2361 x 1568 pixels · FOV: 50 degrees · fundus photo: 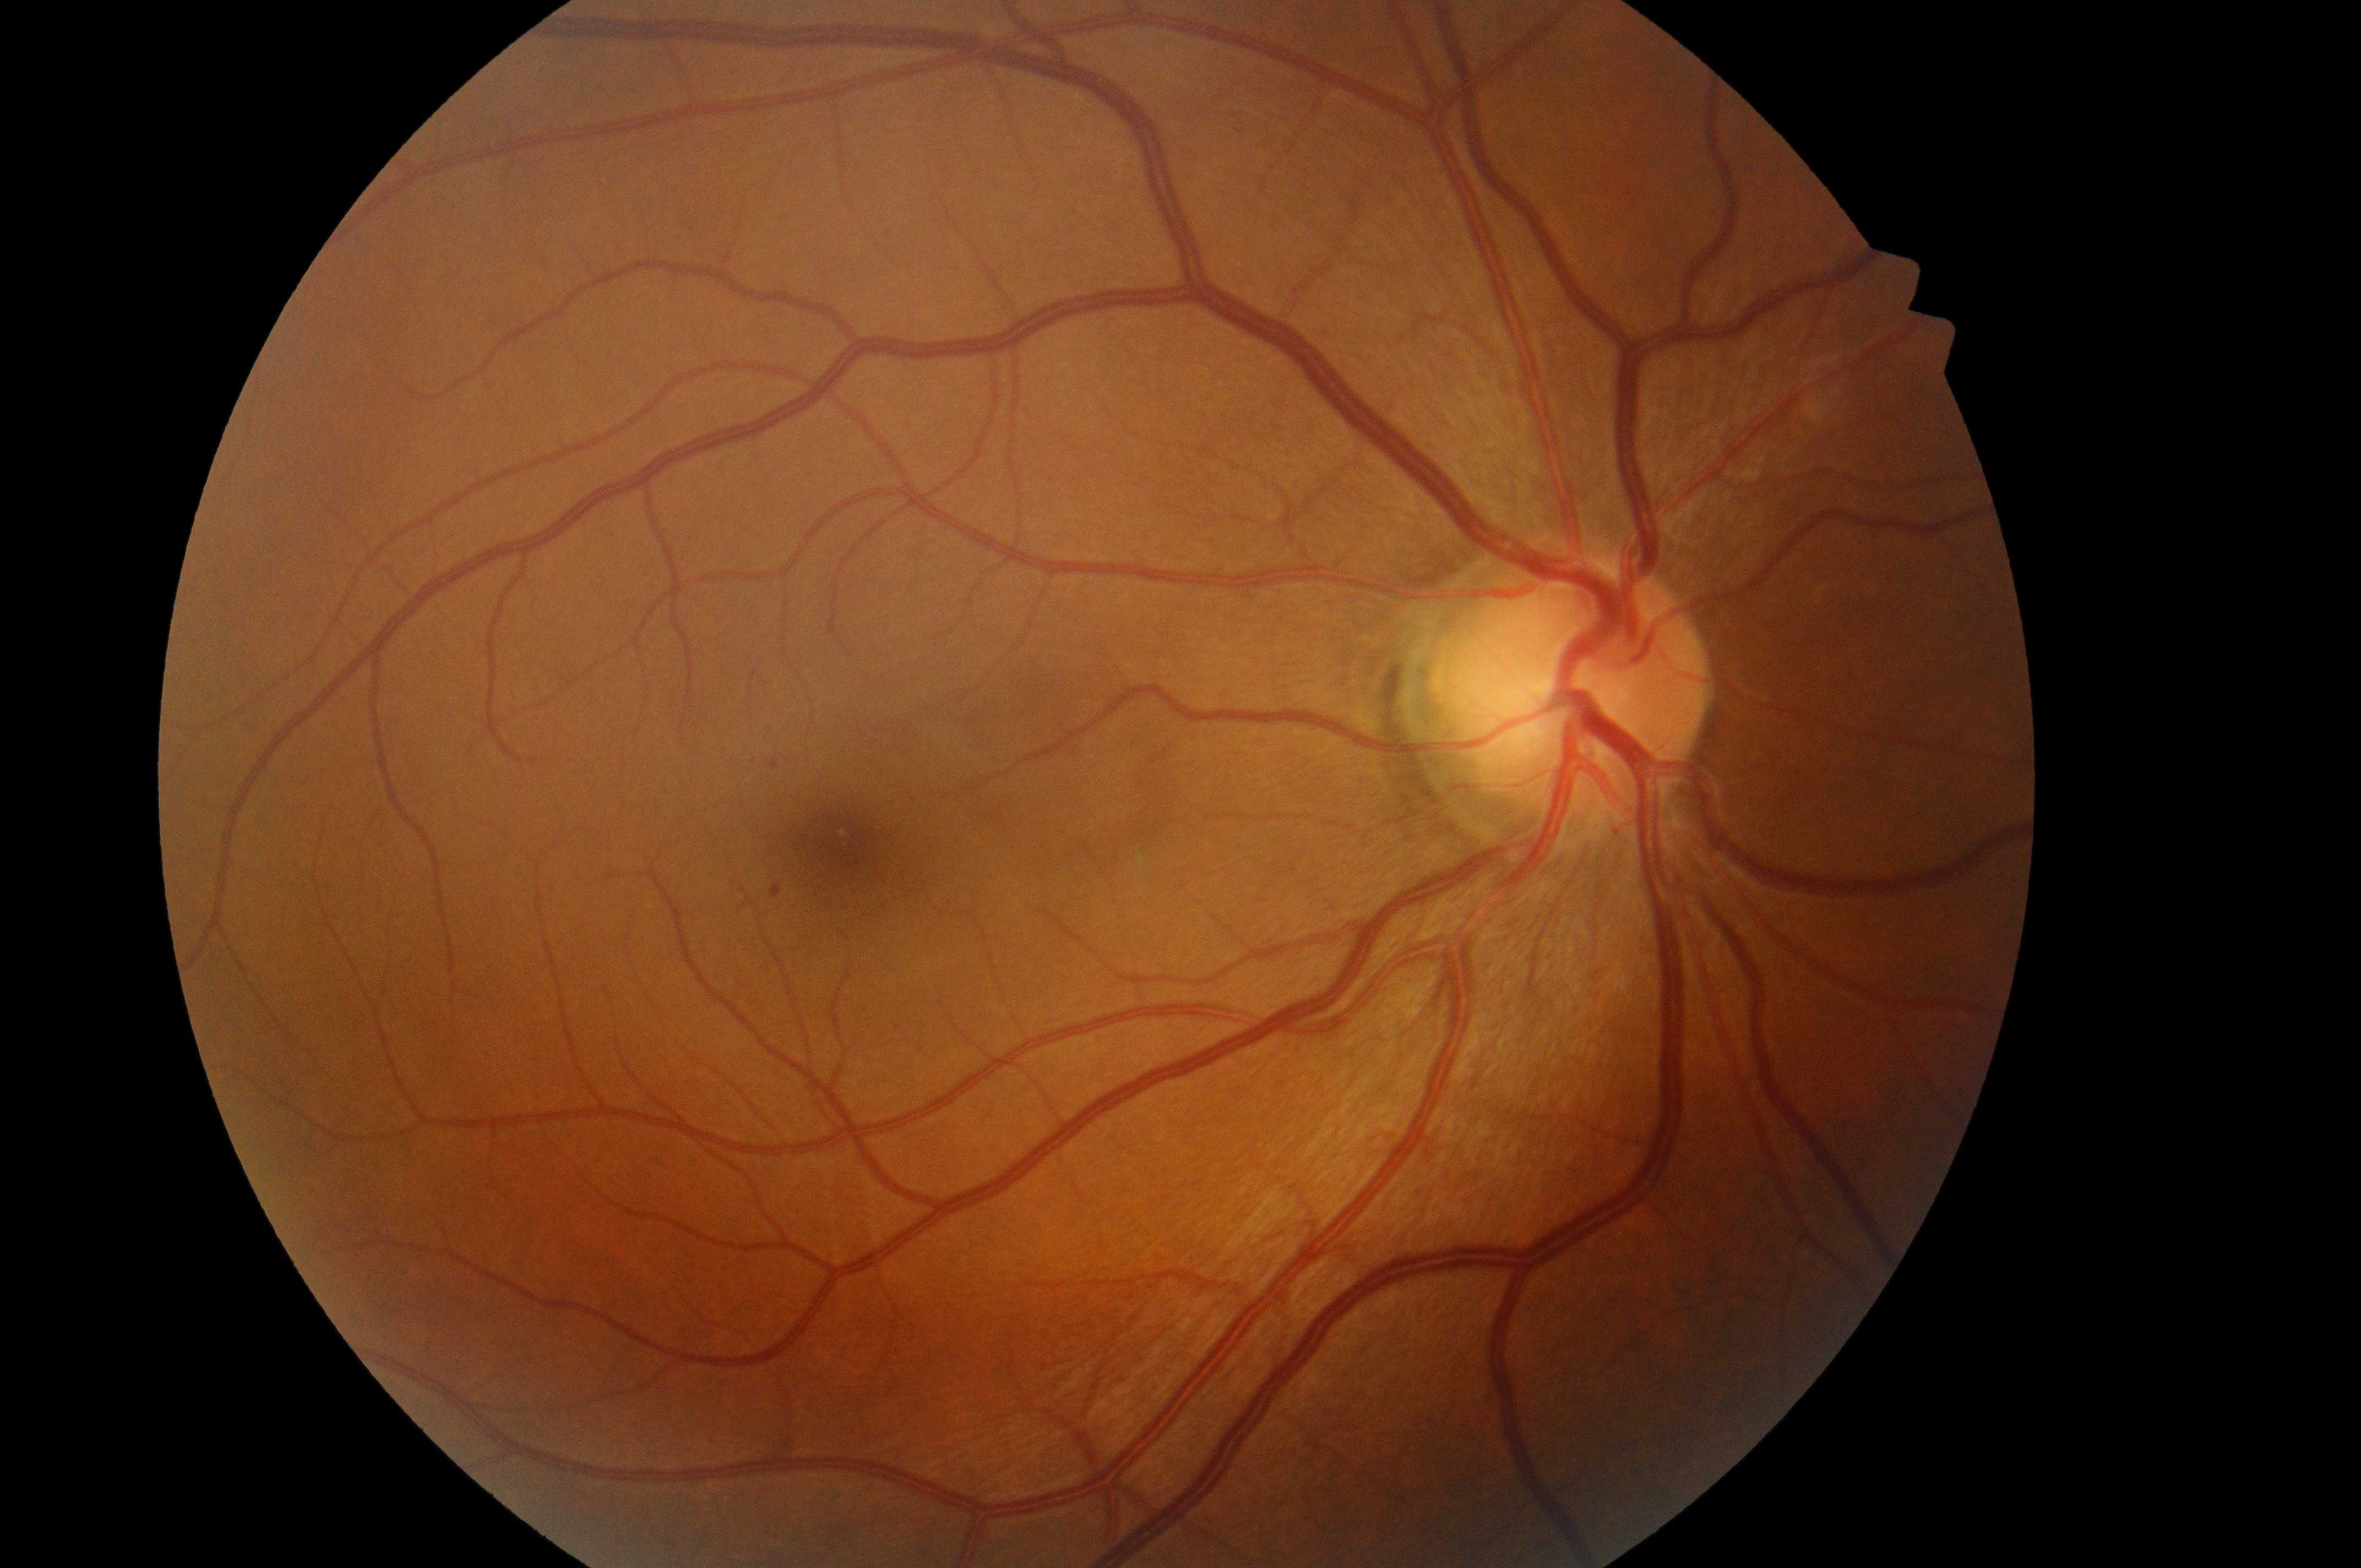 The optic disk is at (x=1564, y=701). The retinopathy is classified as non-proliferative diabetic retinopathy. DR: grade 1. Imaged eye: right eye. Foveal center: (x=846, y=843). DME risk is grade 0.